FOV: 30 degrees · central corneal thickness: 603 µm · refractive error: sphere -0.5 D, cylinder -1.5 D, axis 88° · patient age: 47 years · intraocular pressure 20 mmHg · axial length (AL): 23.77 mm
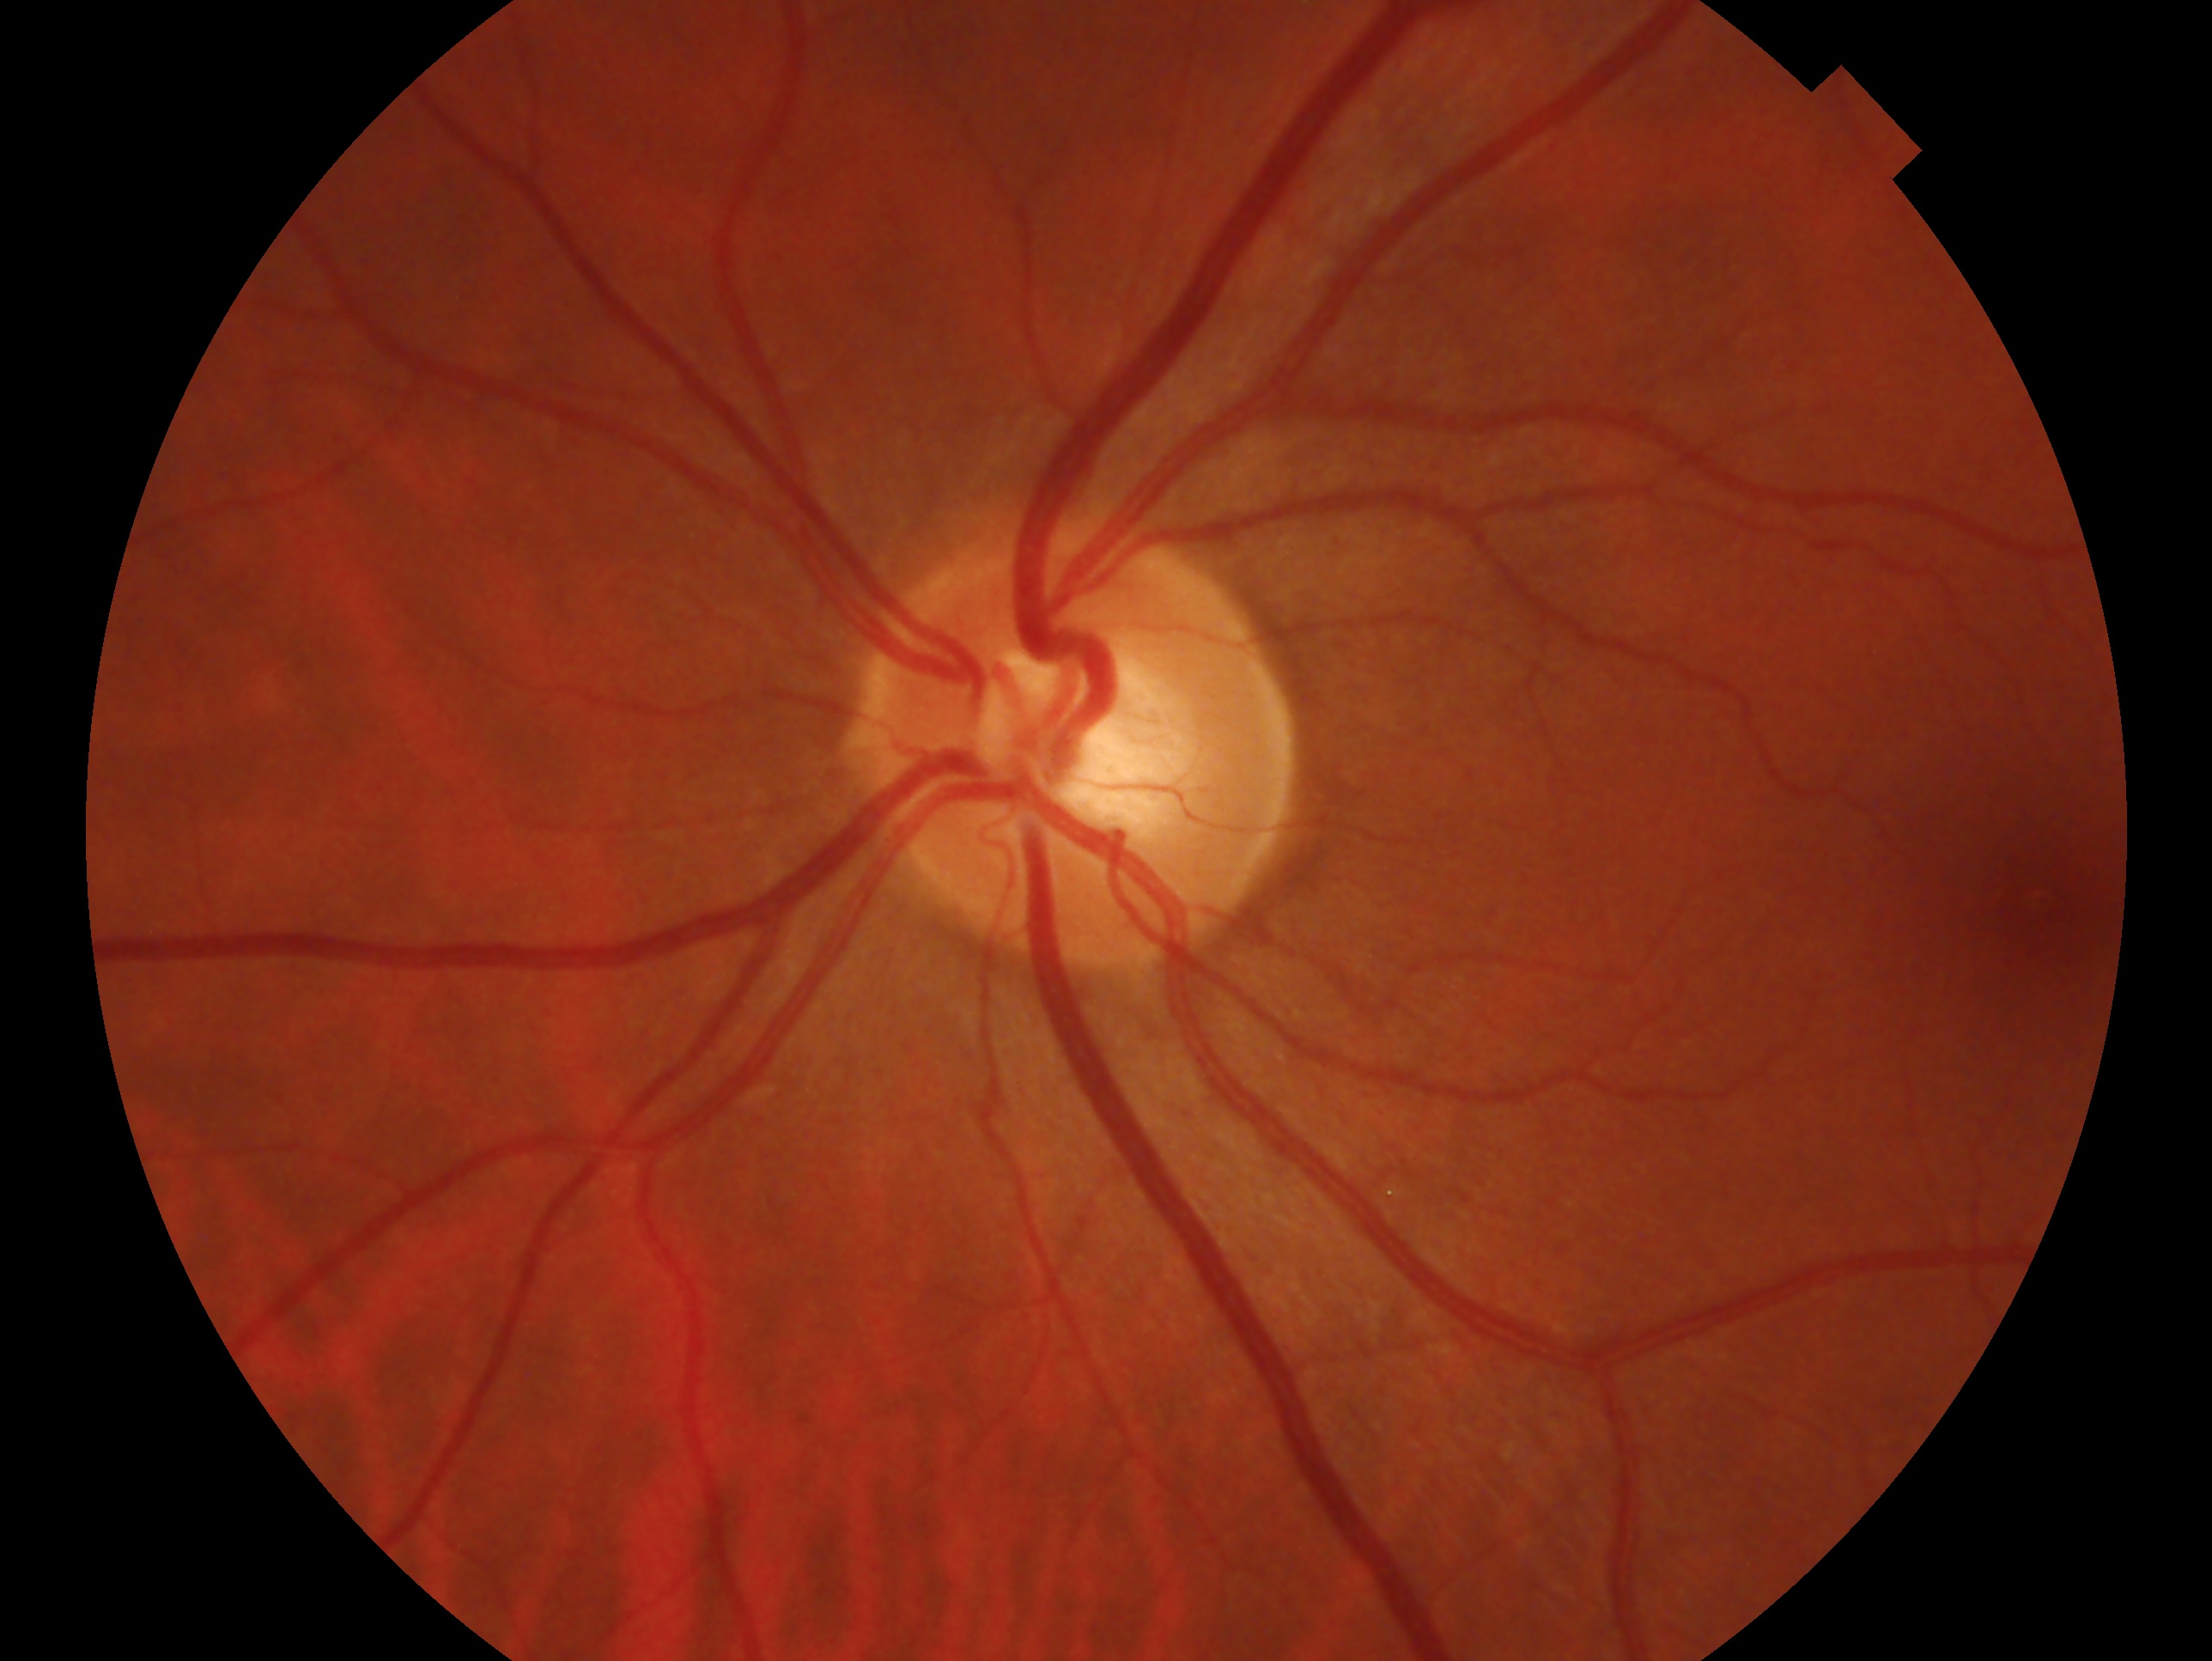
– laterality — left eye
– glaucoma status — suspect